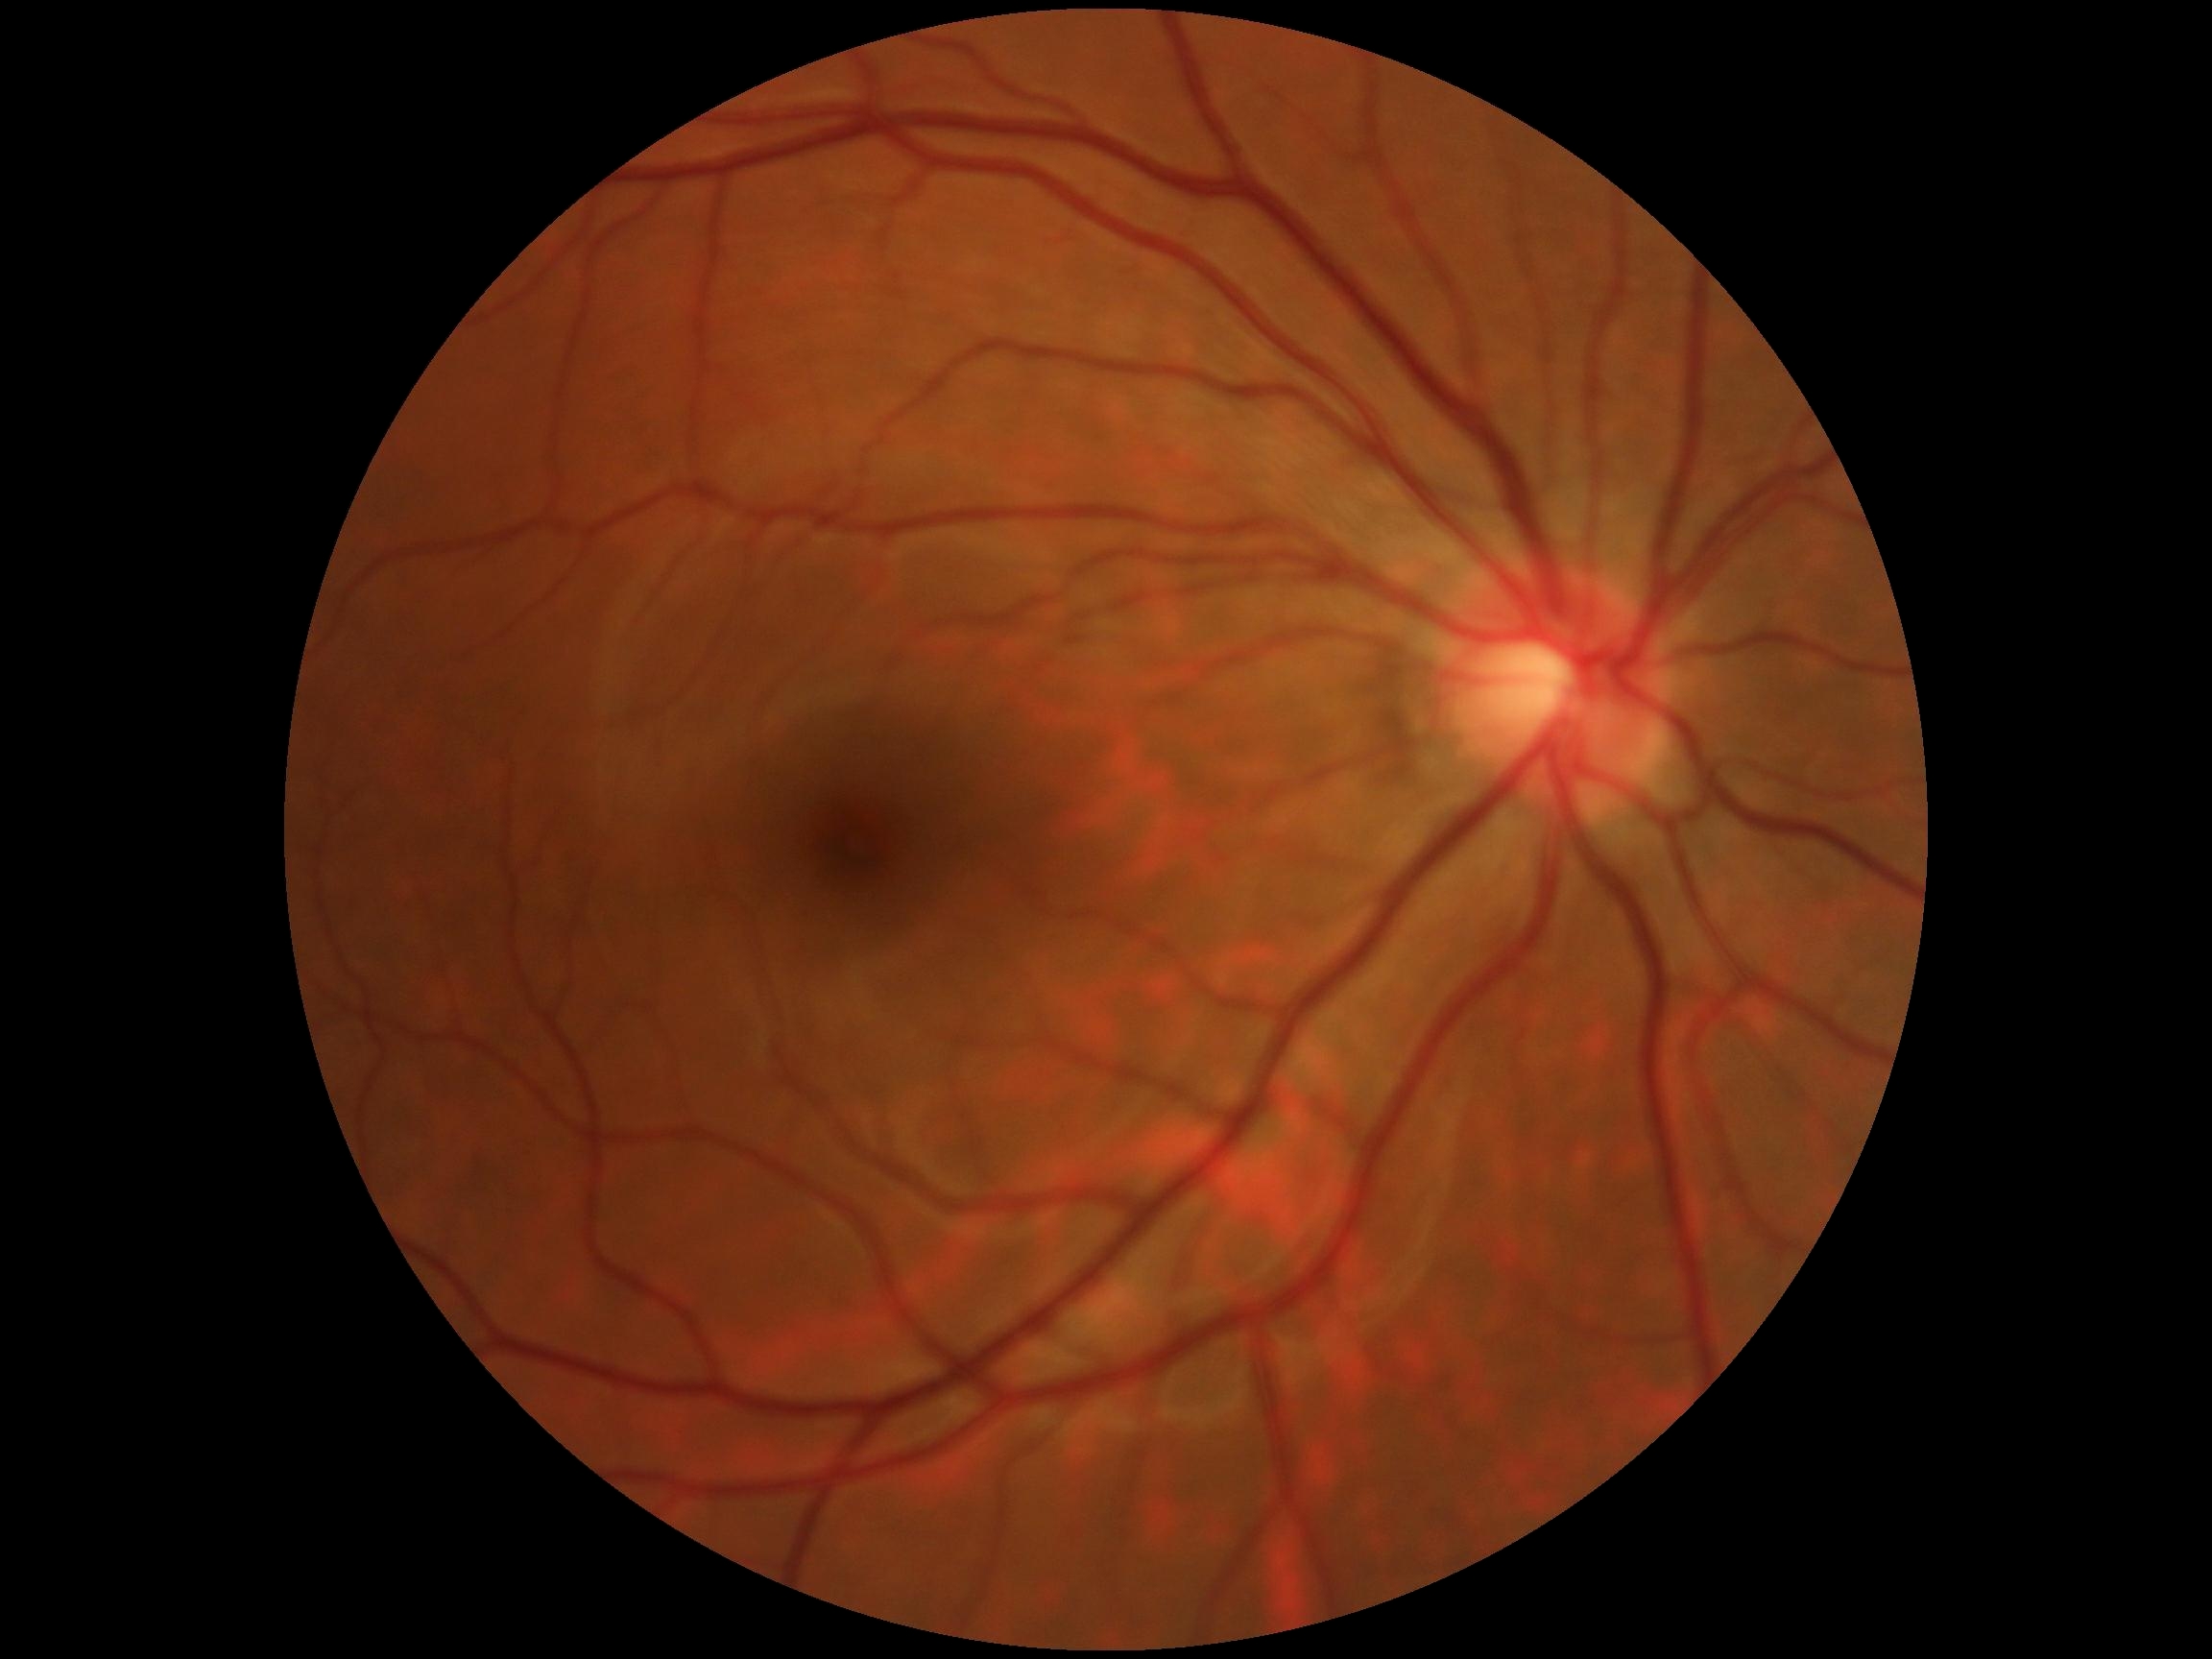
{
  "dr_grade": "0/4"
}